Mydriatic, optic disc region of a color fundus photo, 35° FOV before cropping.
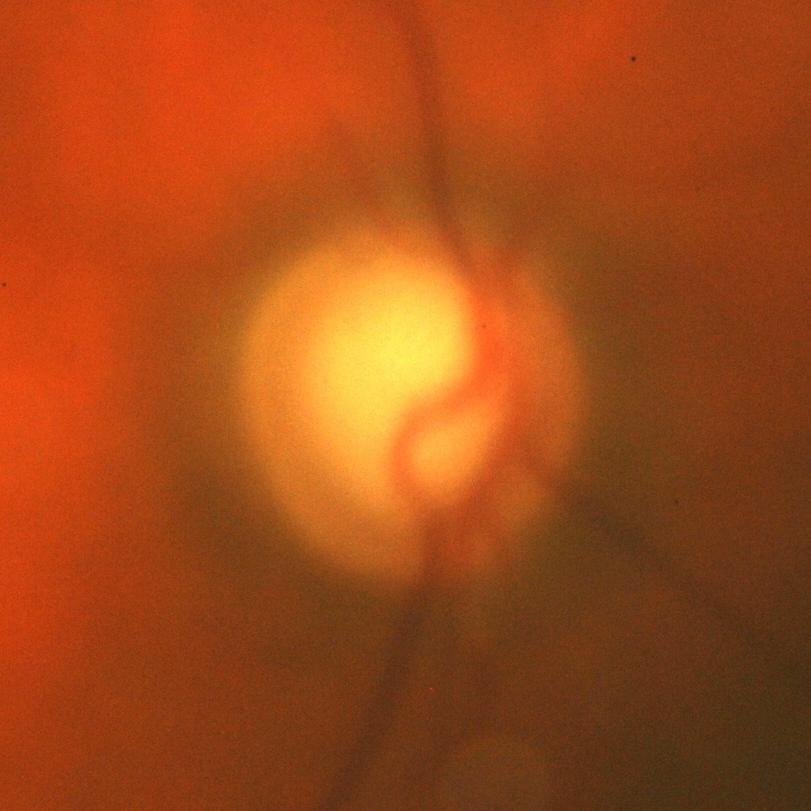

Q: Is glaucoma present?
A: Yes — evidence of glaucoma.